640x480px. Wide-field fundus image from infant ROP screening.
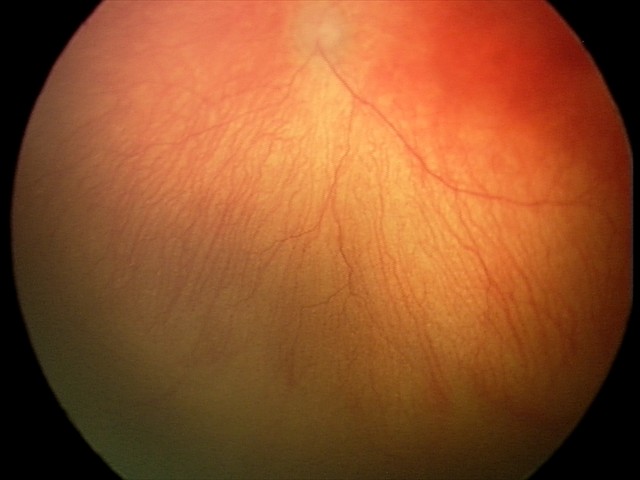 Plus disease was diagnosed.
Series diagnosed as aggressive ROP (A-ROP) — rapidly progressive severe ROP with prominent plus disease, often without classic stage progression.